Image size 1240x1240; Phoenix ICON wide-field infant fundus image; 100° field of view (Phoenix ICON):
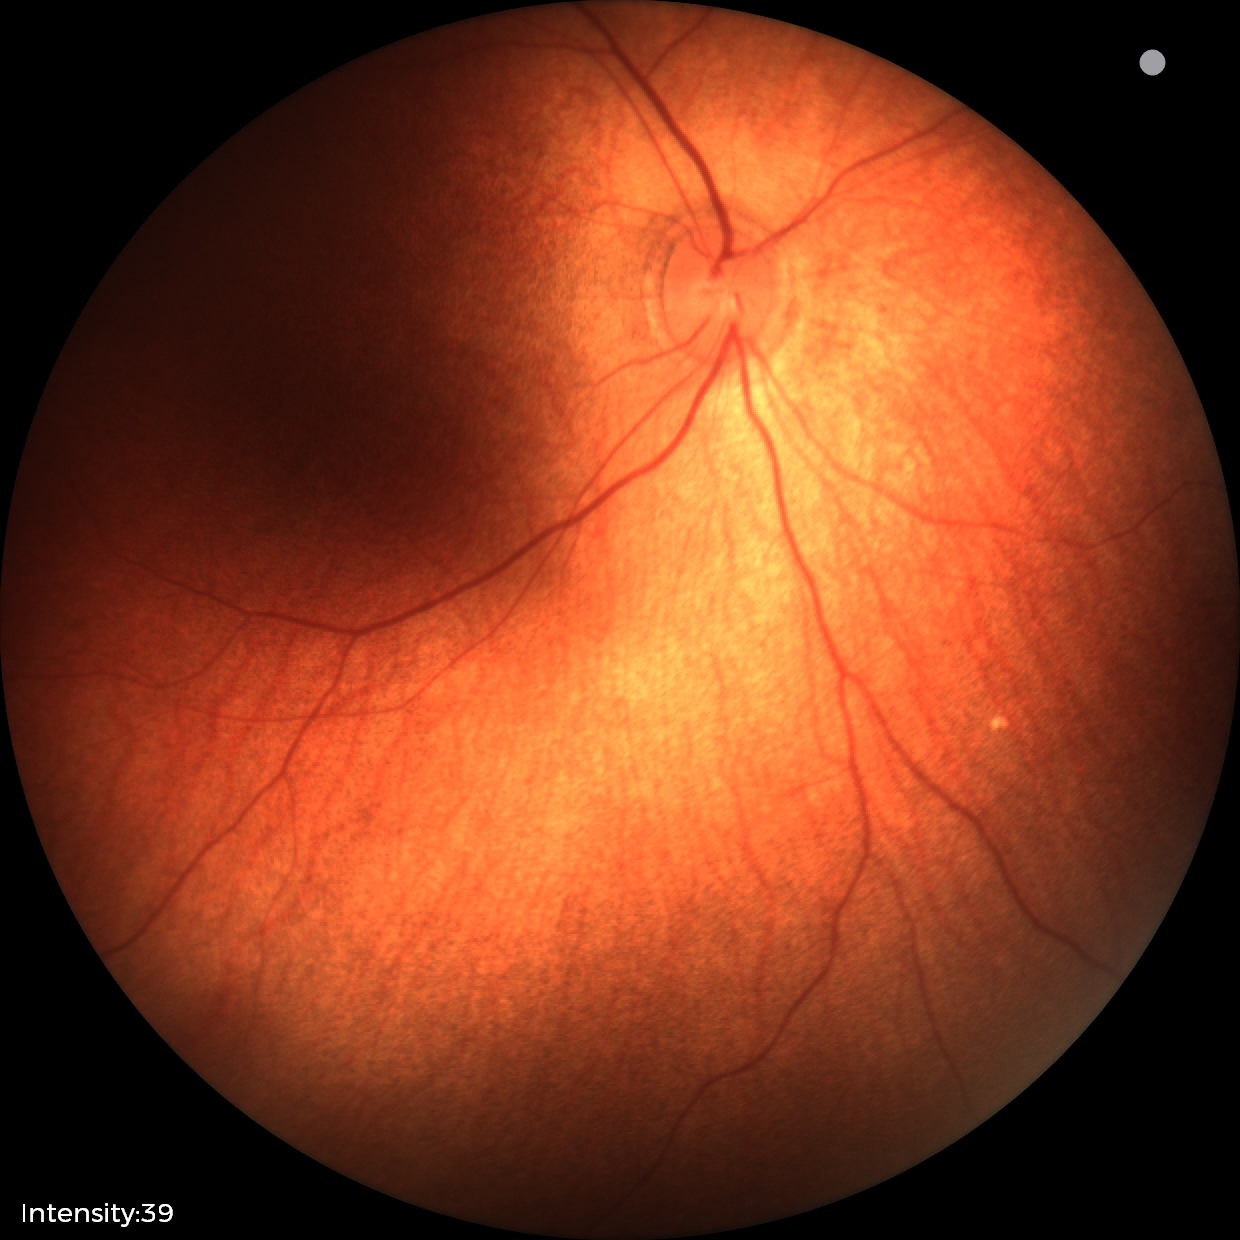

Physiological retinal appearance for postconceptual age.